Color fundus photograph, image size 848x848.
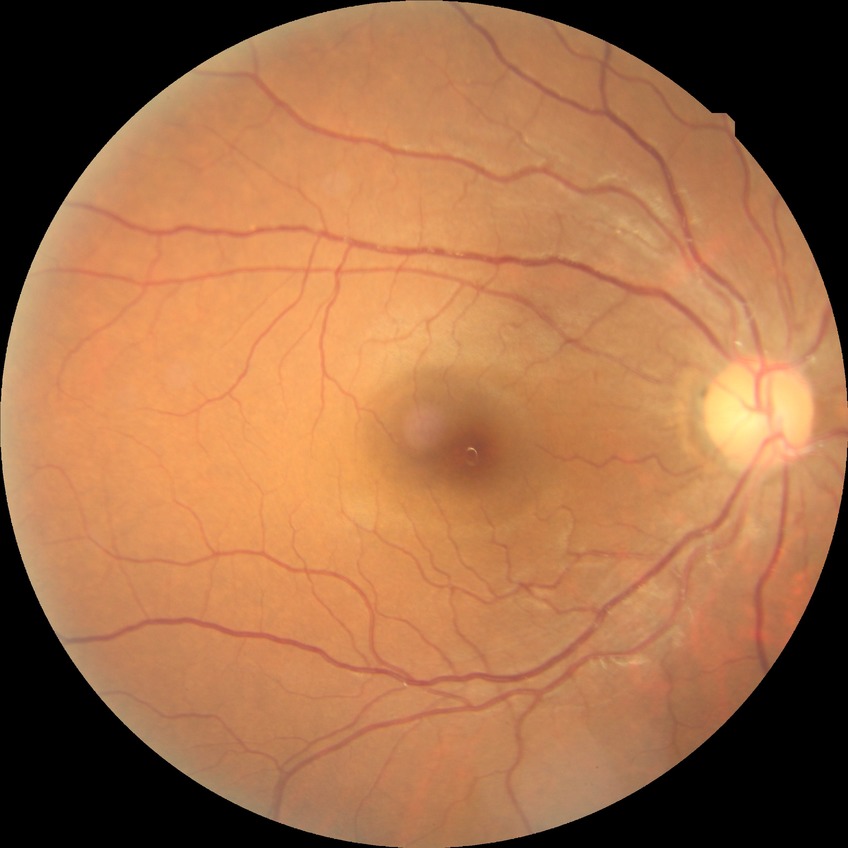 – diabetic retinopathy stage — no diabetic retinopathy